Wide-field fundus image from infant ROP screening.
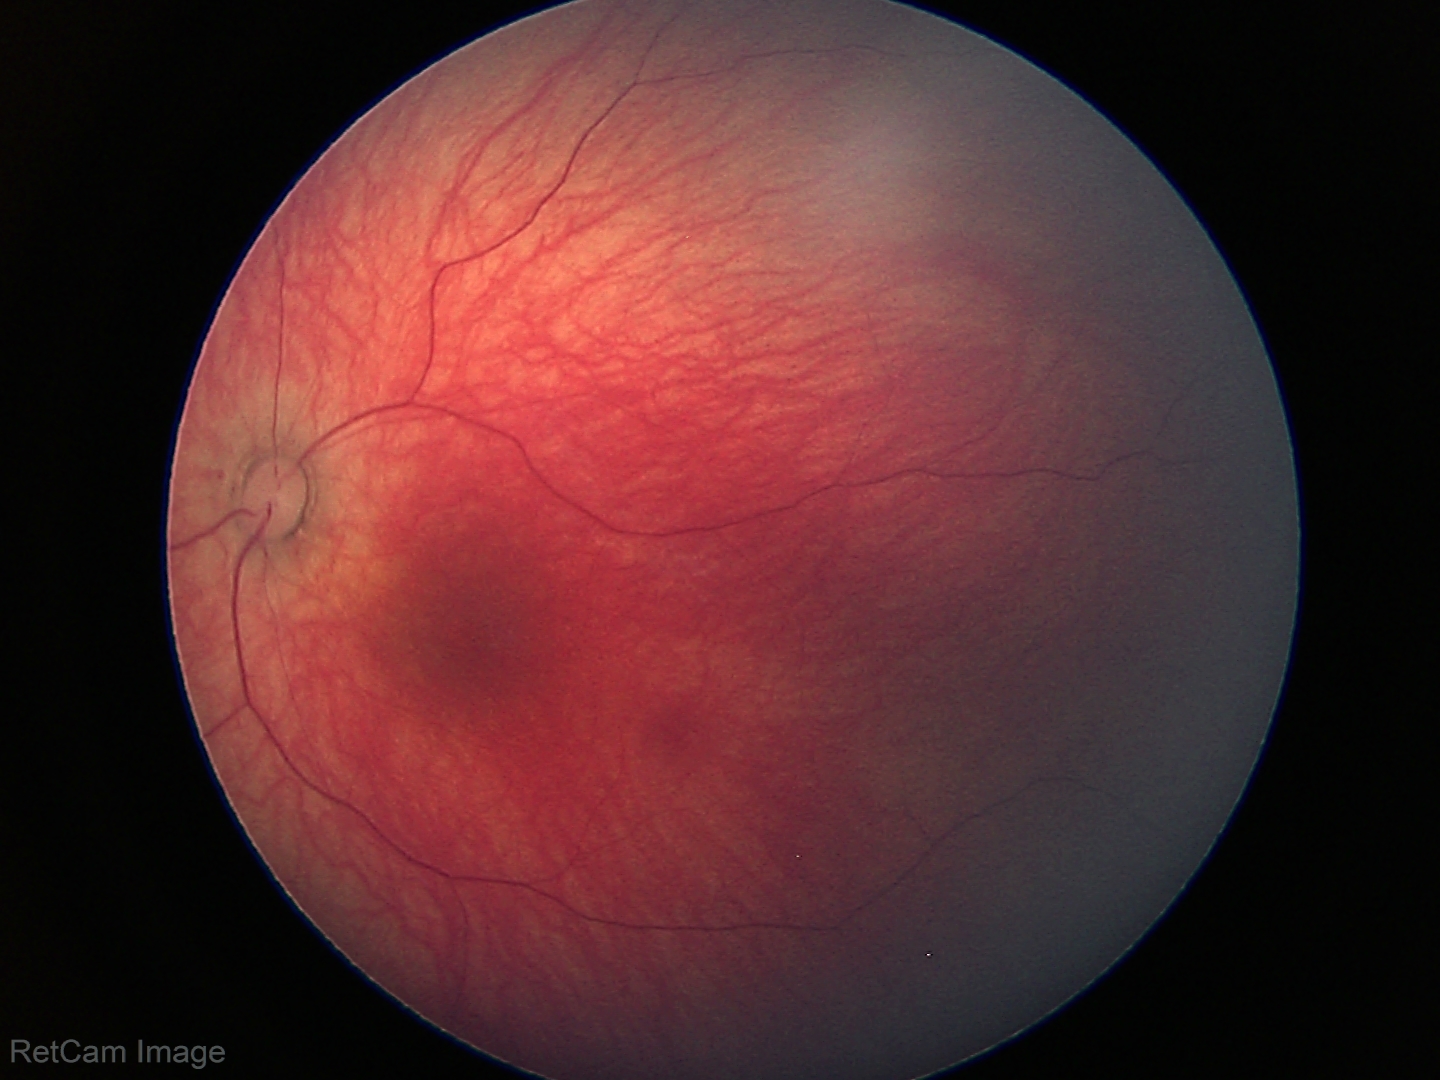
No retinal pathology identified on screening.